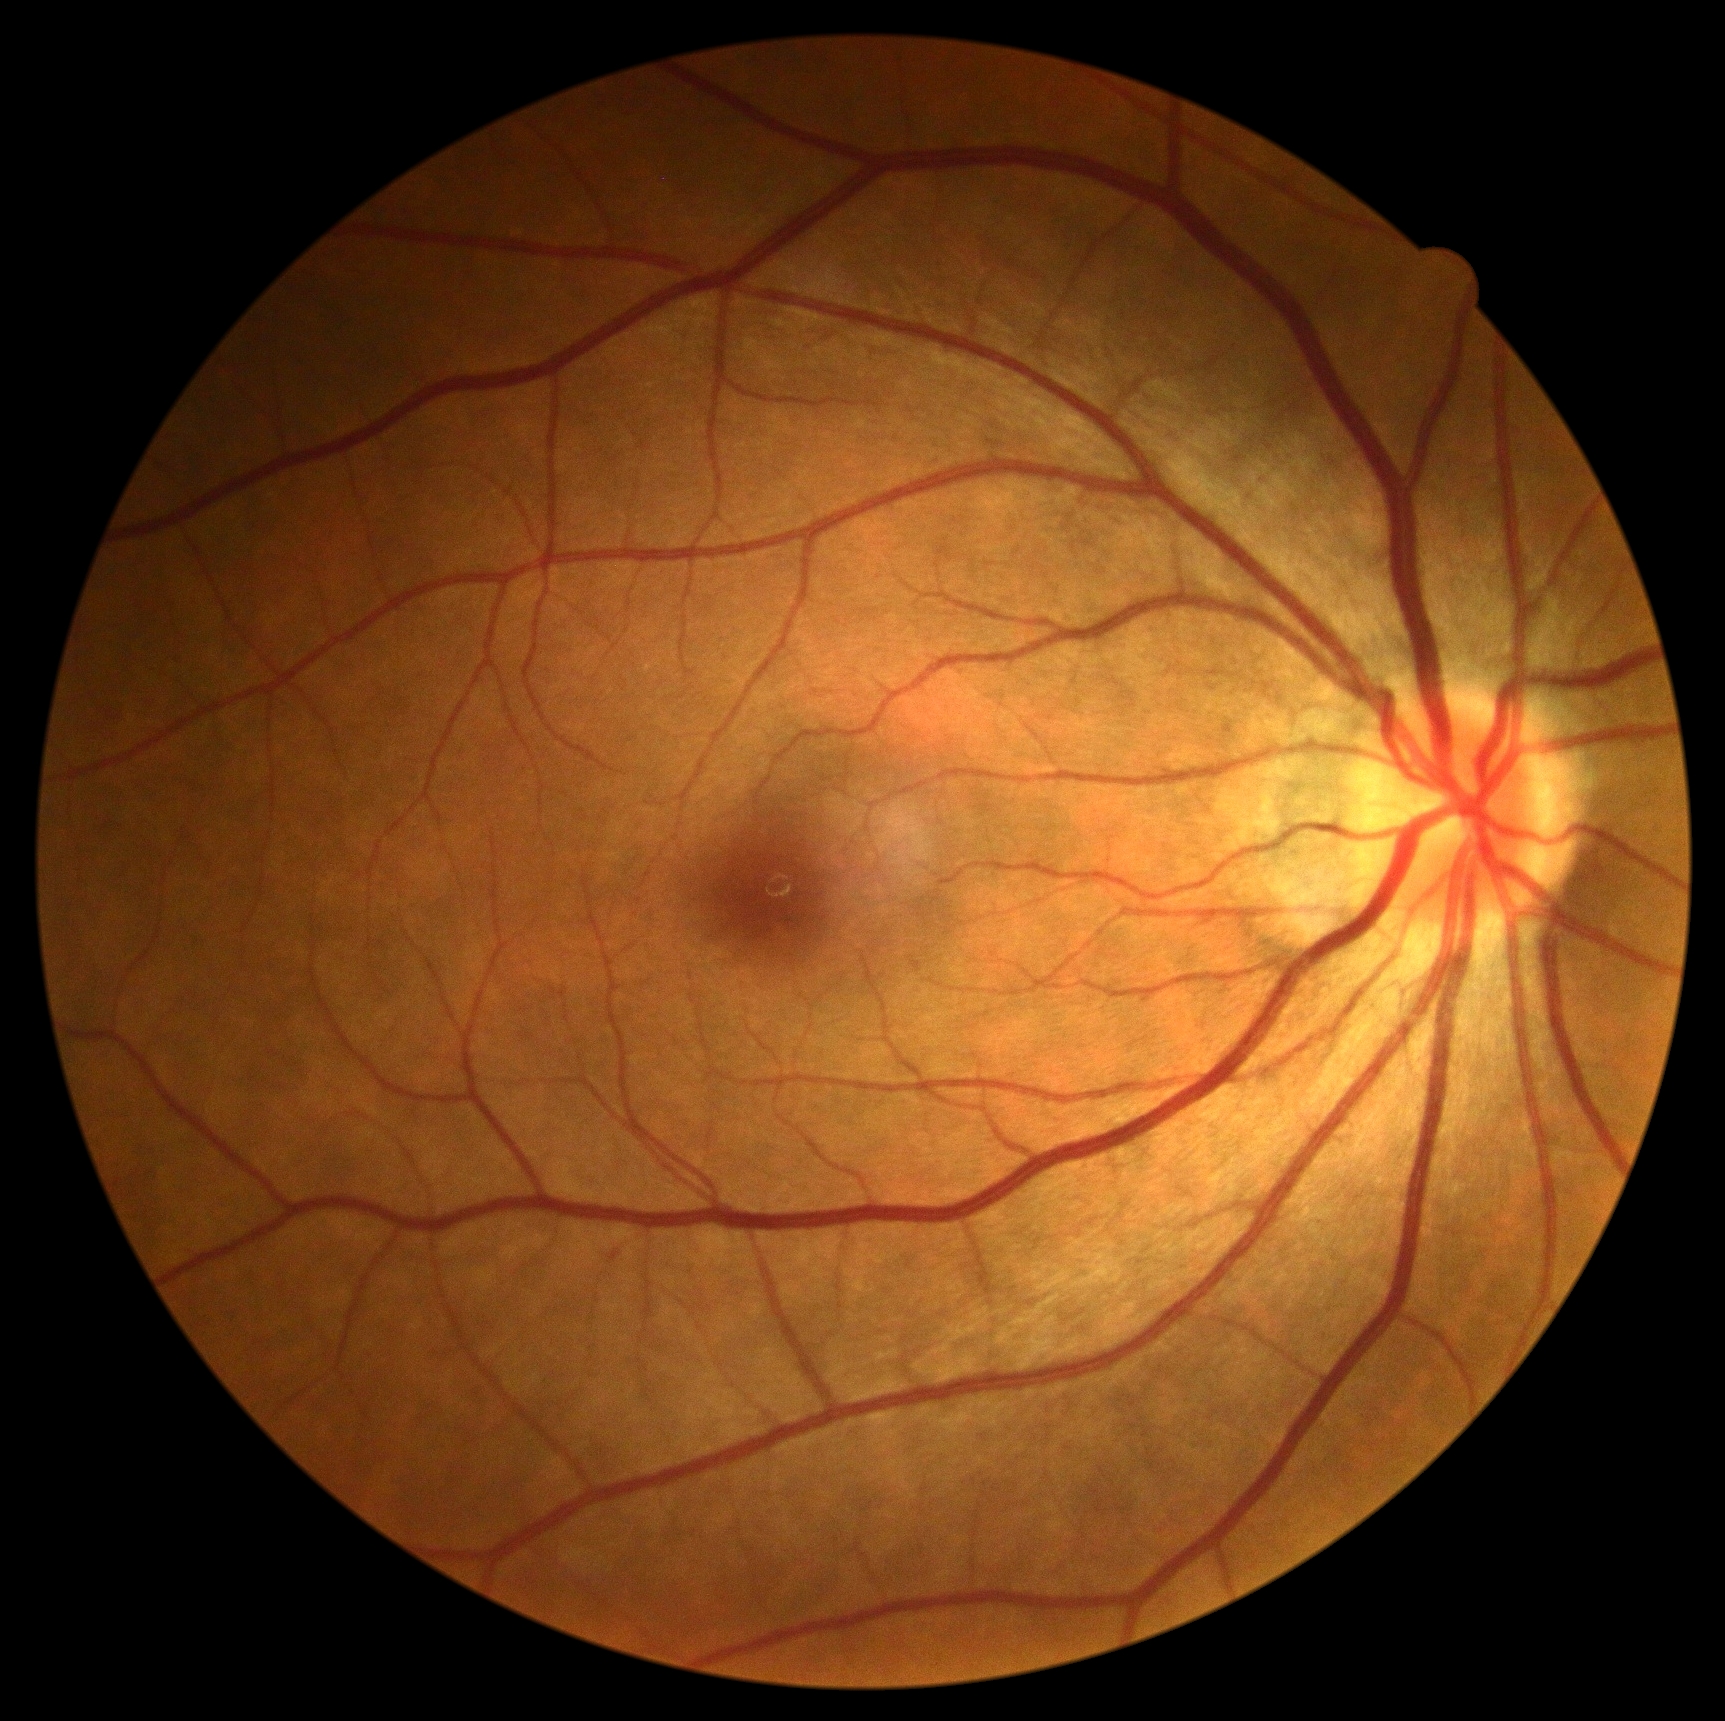 DR: grade 0.